Fundus photo; FOV: 45 degrees; image size 2352x1568 — 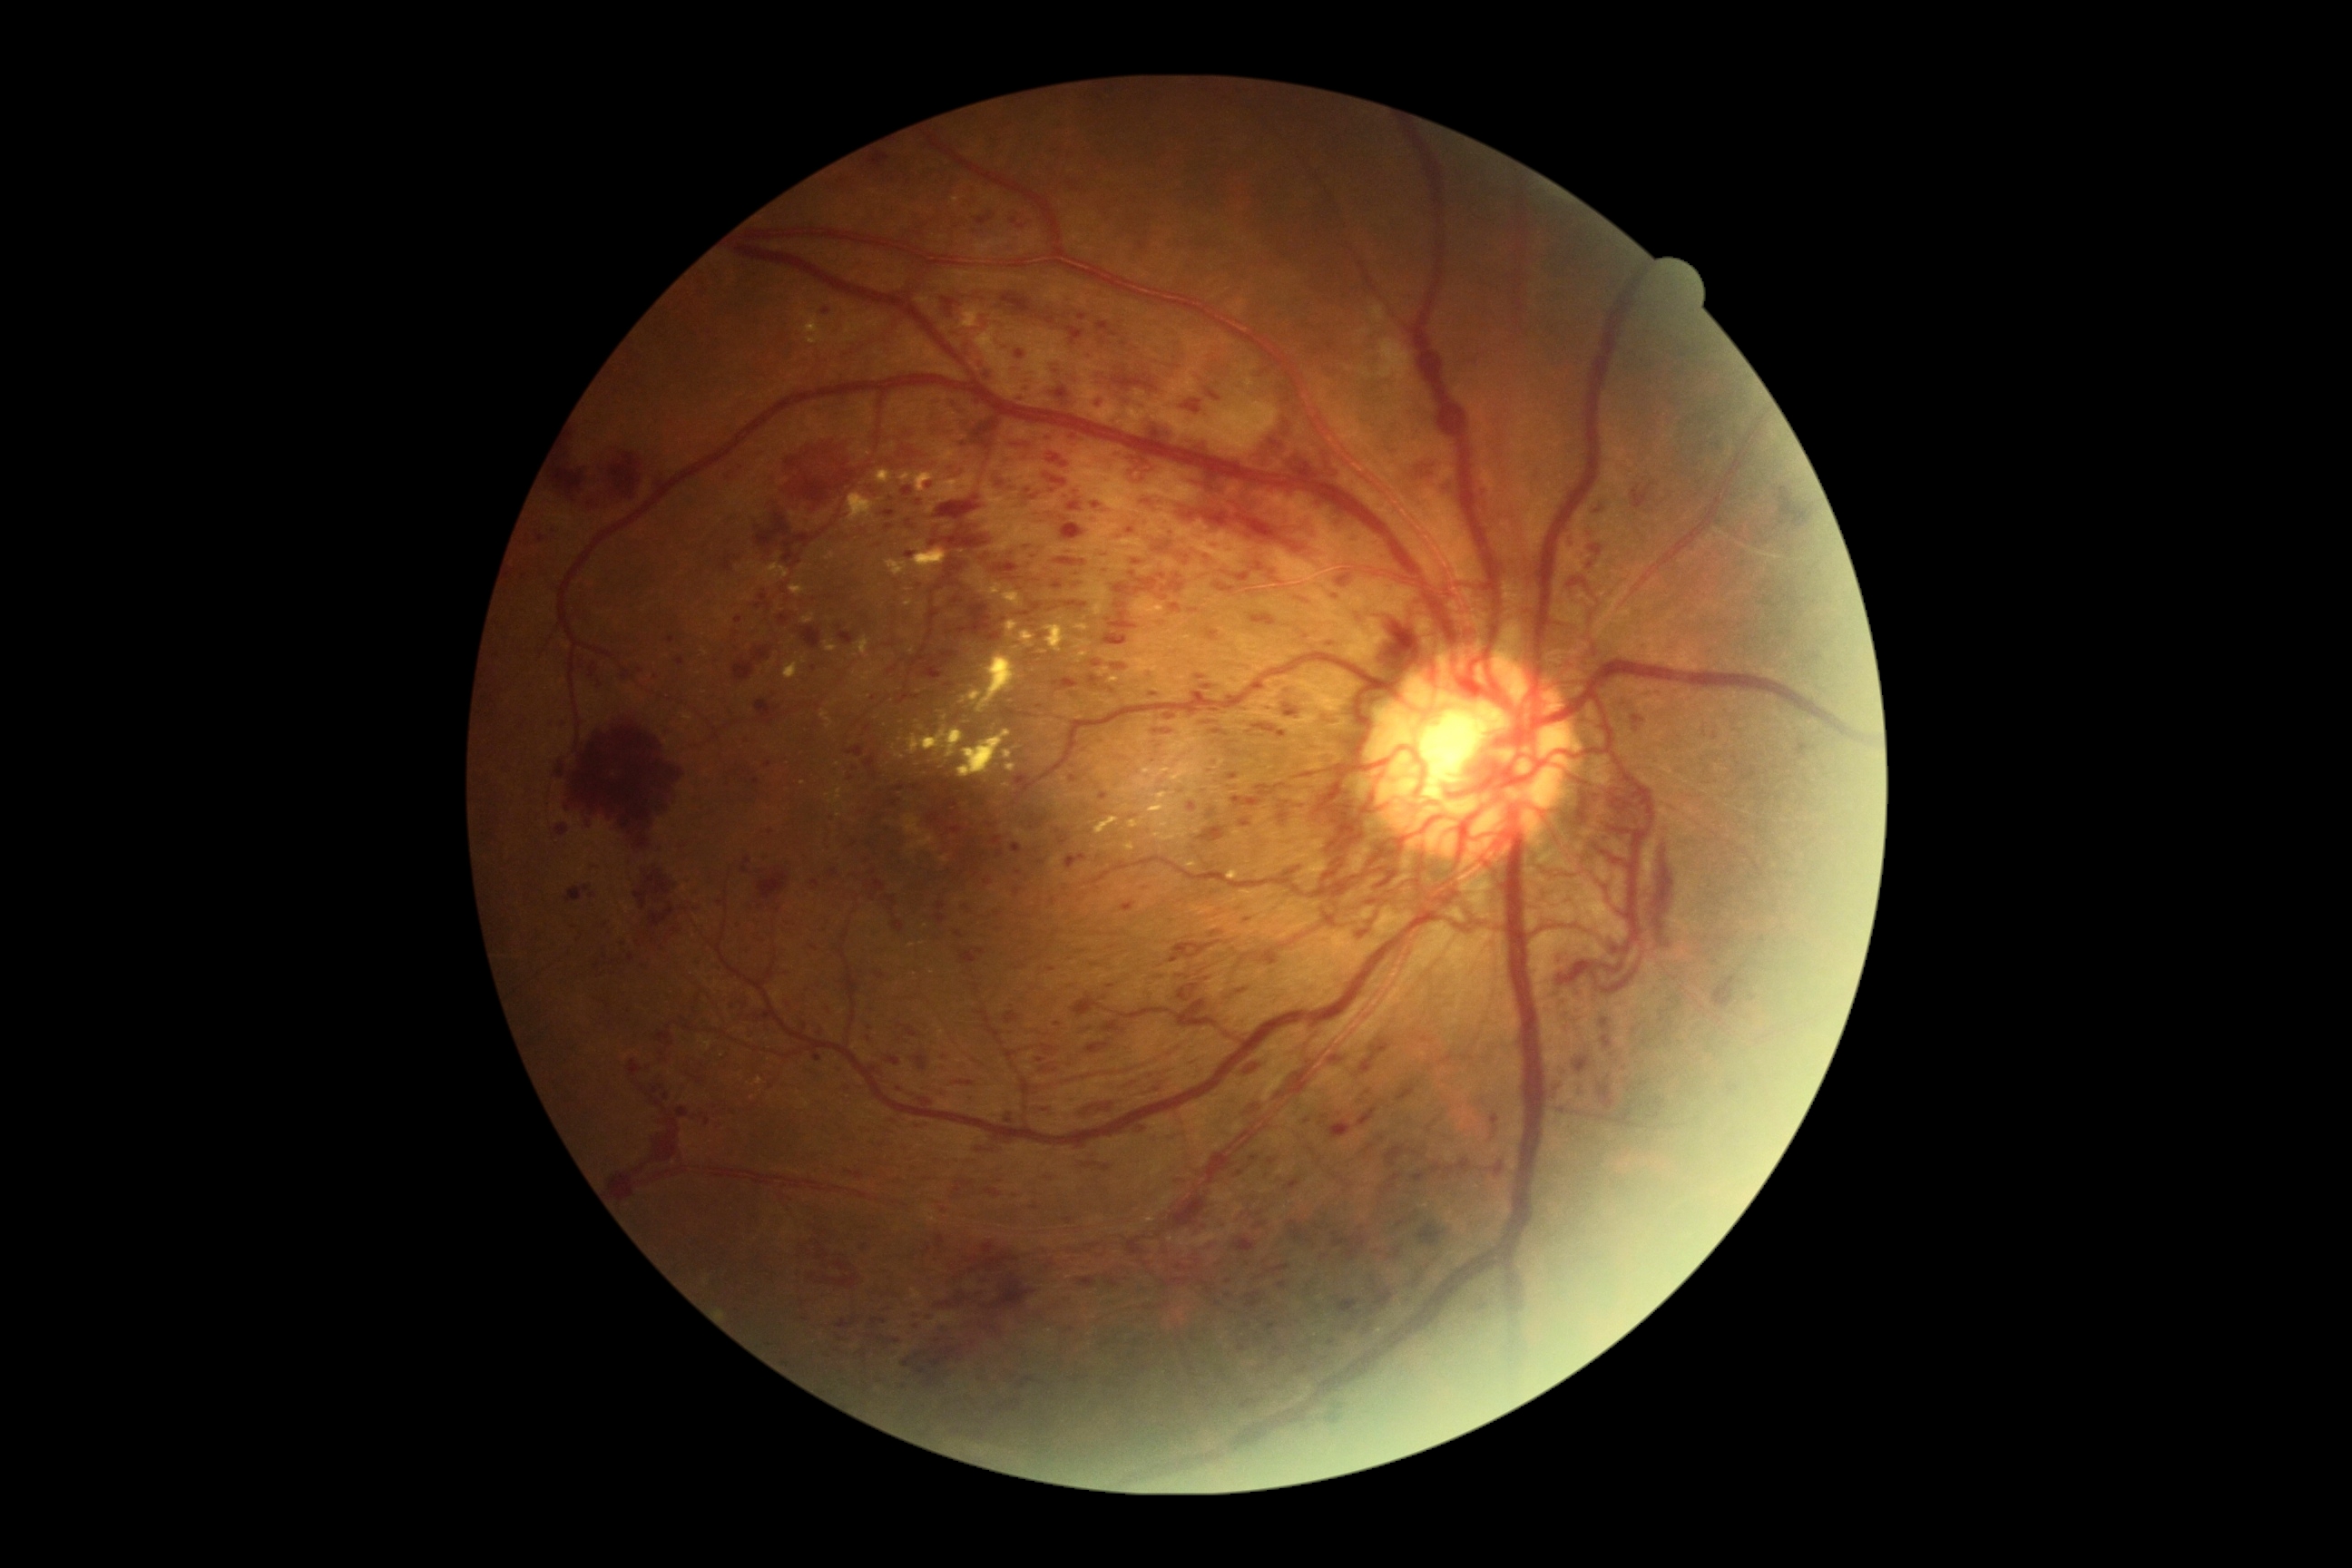

Diabetic retinopathy (DR) is grade 4 (PDR) — neovascularization and/or vitreous/pre-retinal hemorrhage. Hemorrhages (HEs) include {"left": 1279, "top": 812, "right": 1289, "bottom": 823} | {"left": 1044, "top": 475, "right": 1068, "bottom": 487} | {"left": 1171, "top": 1191, "right": 1208, "bottom": 1230} | {"left": 1602, "top": 1035, "right": 1614, "bottom": 1050} | {"left": 1306, "top": 1239, "right": 1315, "bottom": 1244} | {"left": 1206, "top": 1128, "right": 1259, "bottom": 1186} | {"left": 912, "top": 1055, "right": 928, "bottom": 1072} | {"left": 810, "top": 881, "right": 821, "bottom": 888} | {"left": 1491, "top": 1115, "right": 1500, "bottom": 1126} | {"left": 565, "top": 887, "right": 591, "bottom": 905} | {"left": 1279, "top": 1282, "right": 1288, "bottom": 1289} | {"left": 785, "top": 536, "right": 808, "bottom": 562} | {"left": 983, "top": 1188, "right": 1003, "bottom": 1199} | {"left": 1257, "top": 785, "right": 1286, "bottom": 798} | {"left": 887, "top": 1055, "right": 901, "bottom": 1066} | {"left": 1273, "top": 1070, "right": 1306, "bottom": 1097}. Additional small HEs near [1003,620] | [1213,867] | [1195,848].